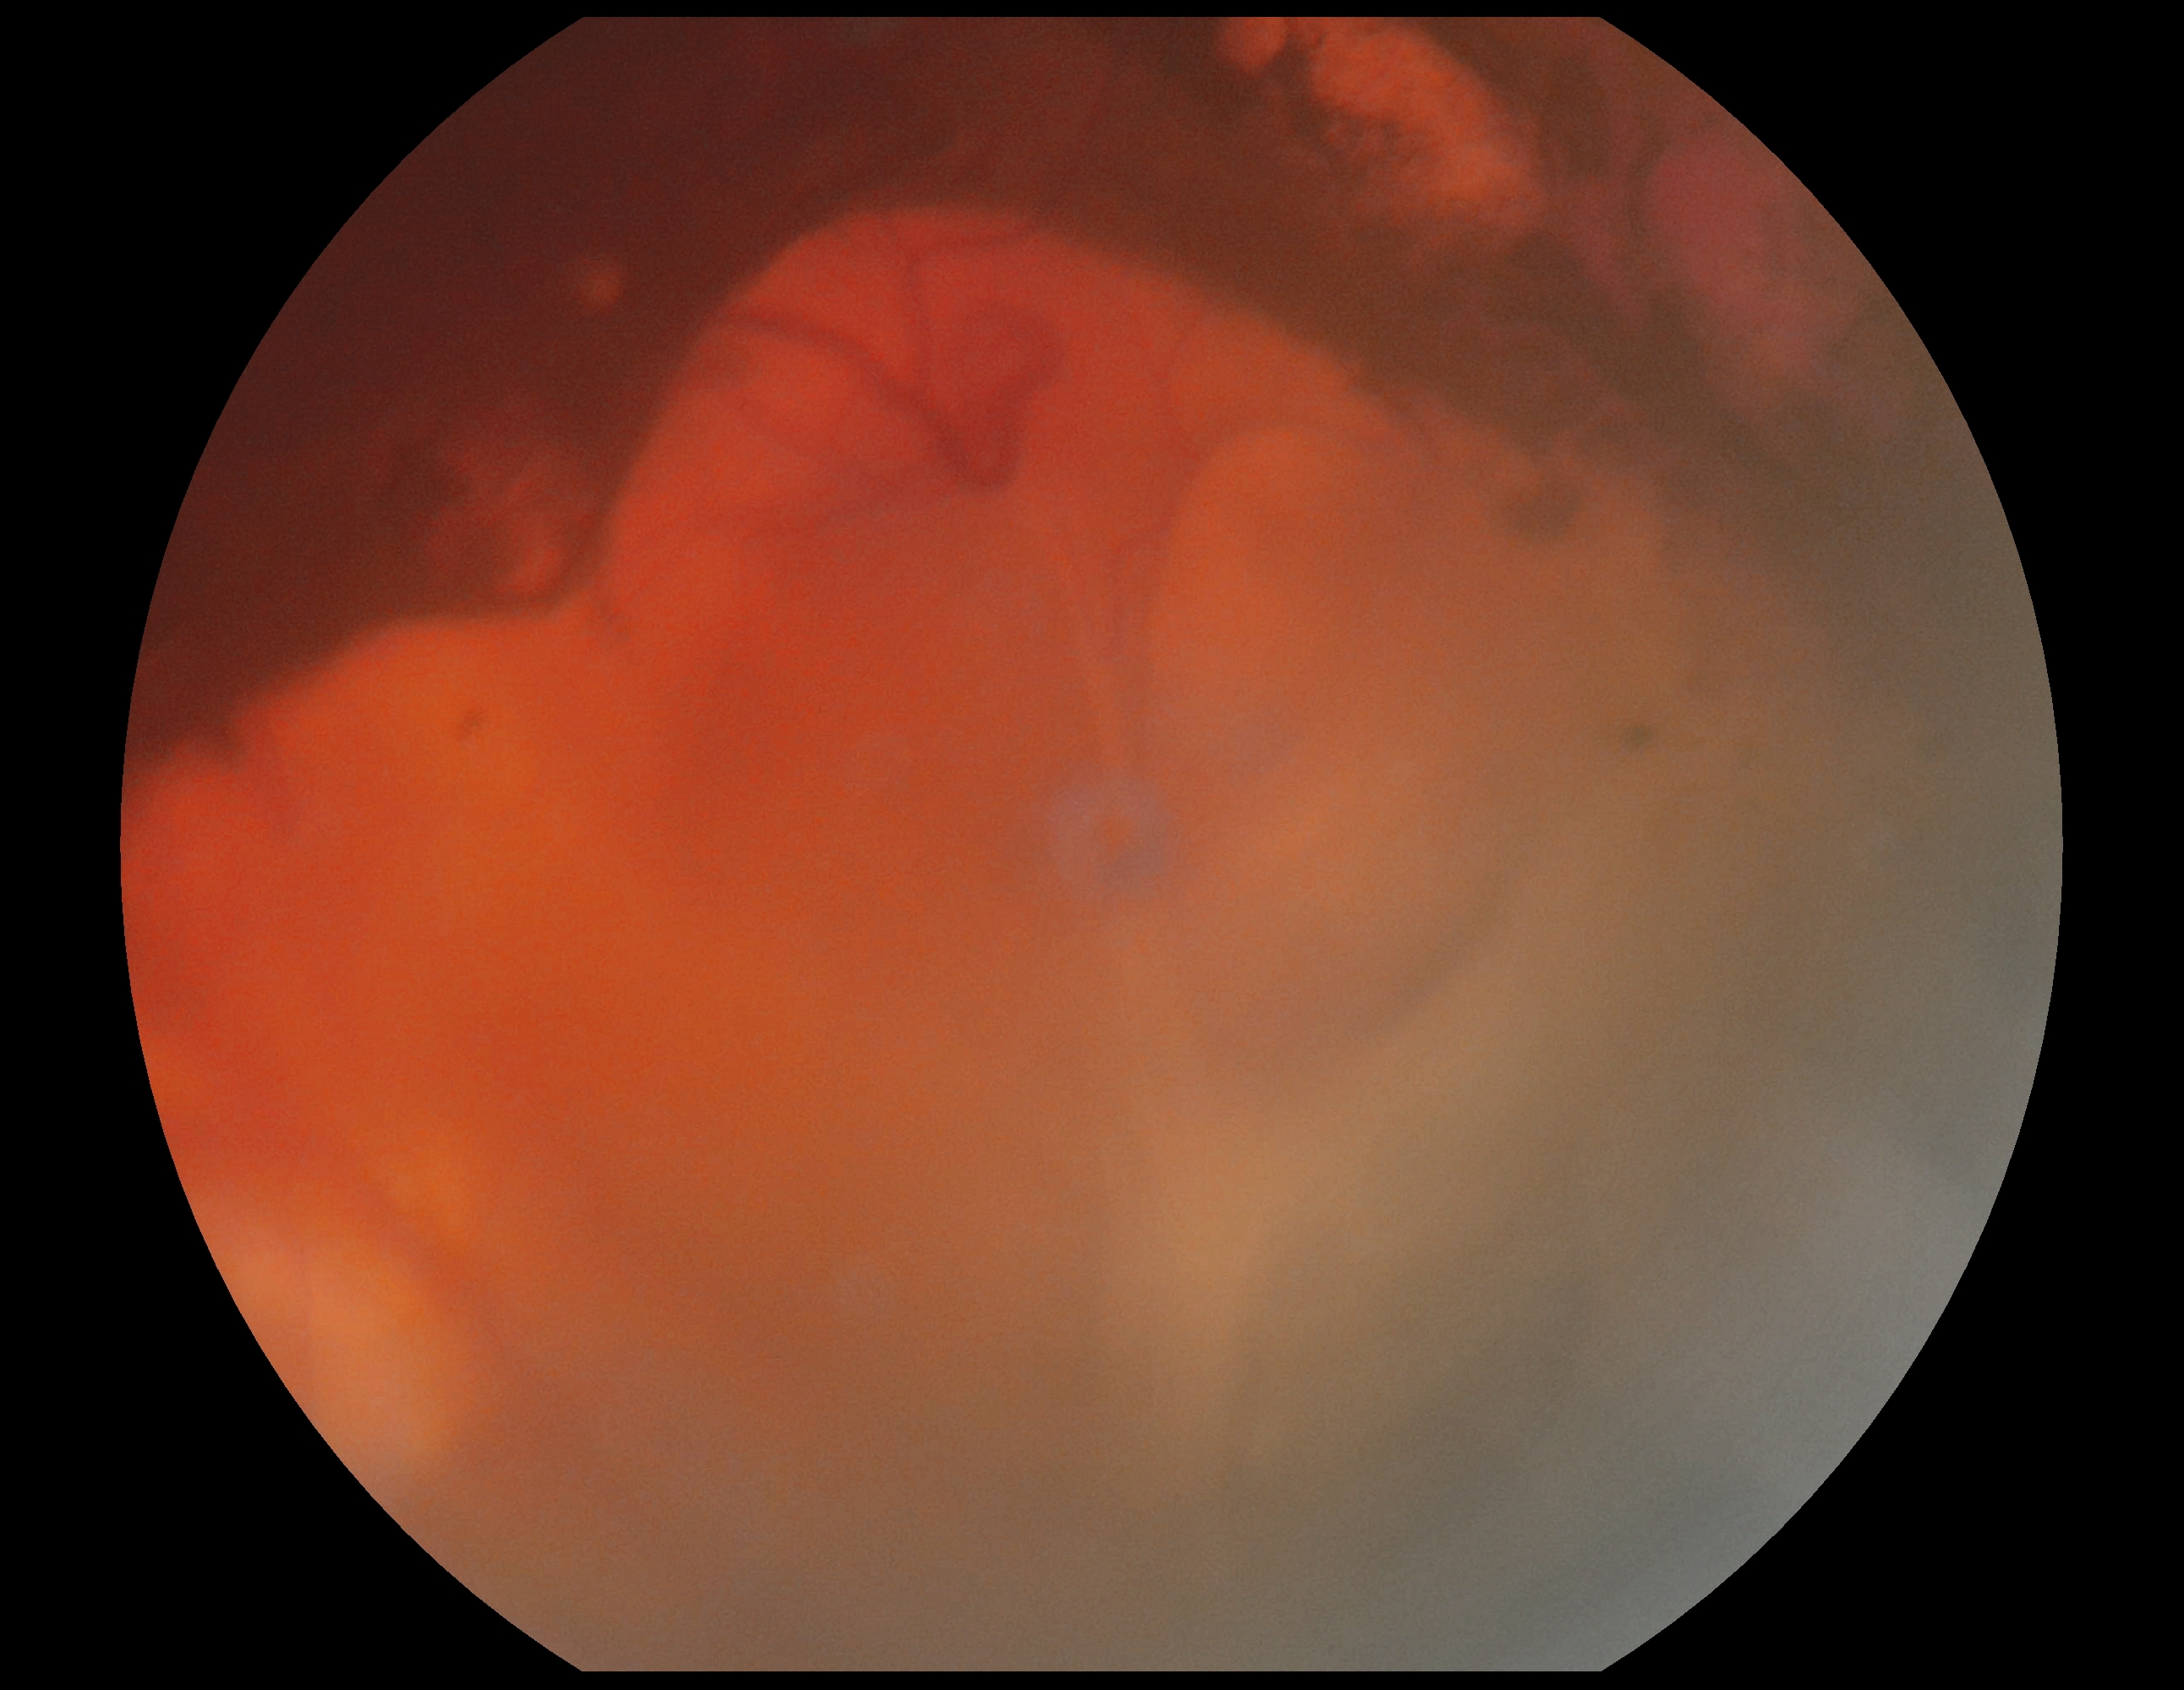

{
  "dr_grade": "4"
}